Davis DR grading
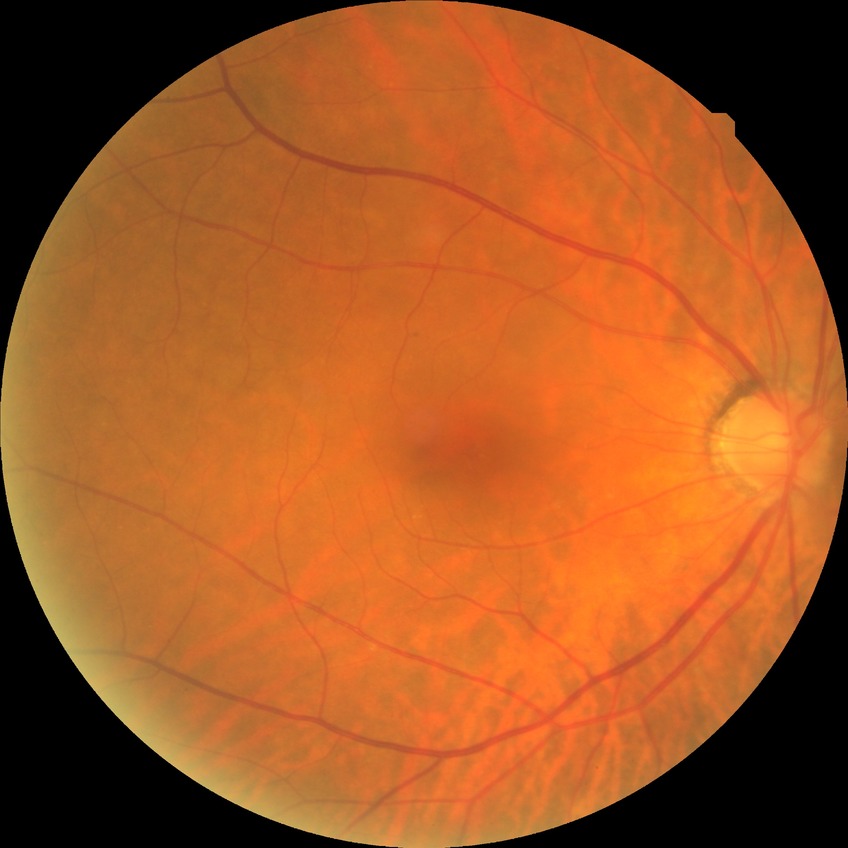
davis_grade: no diabetic retinopathy